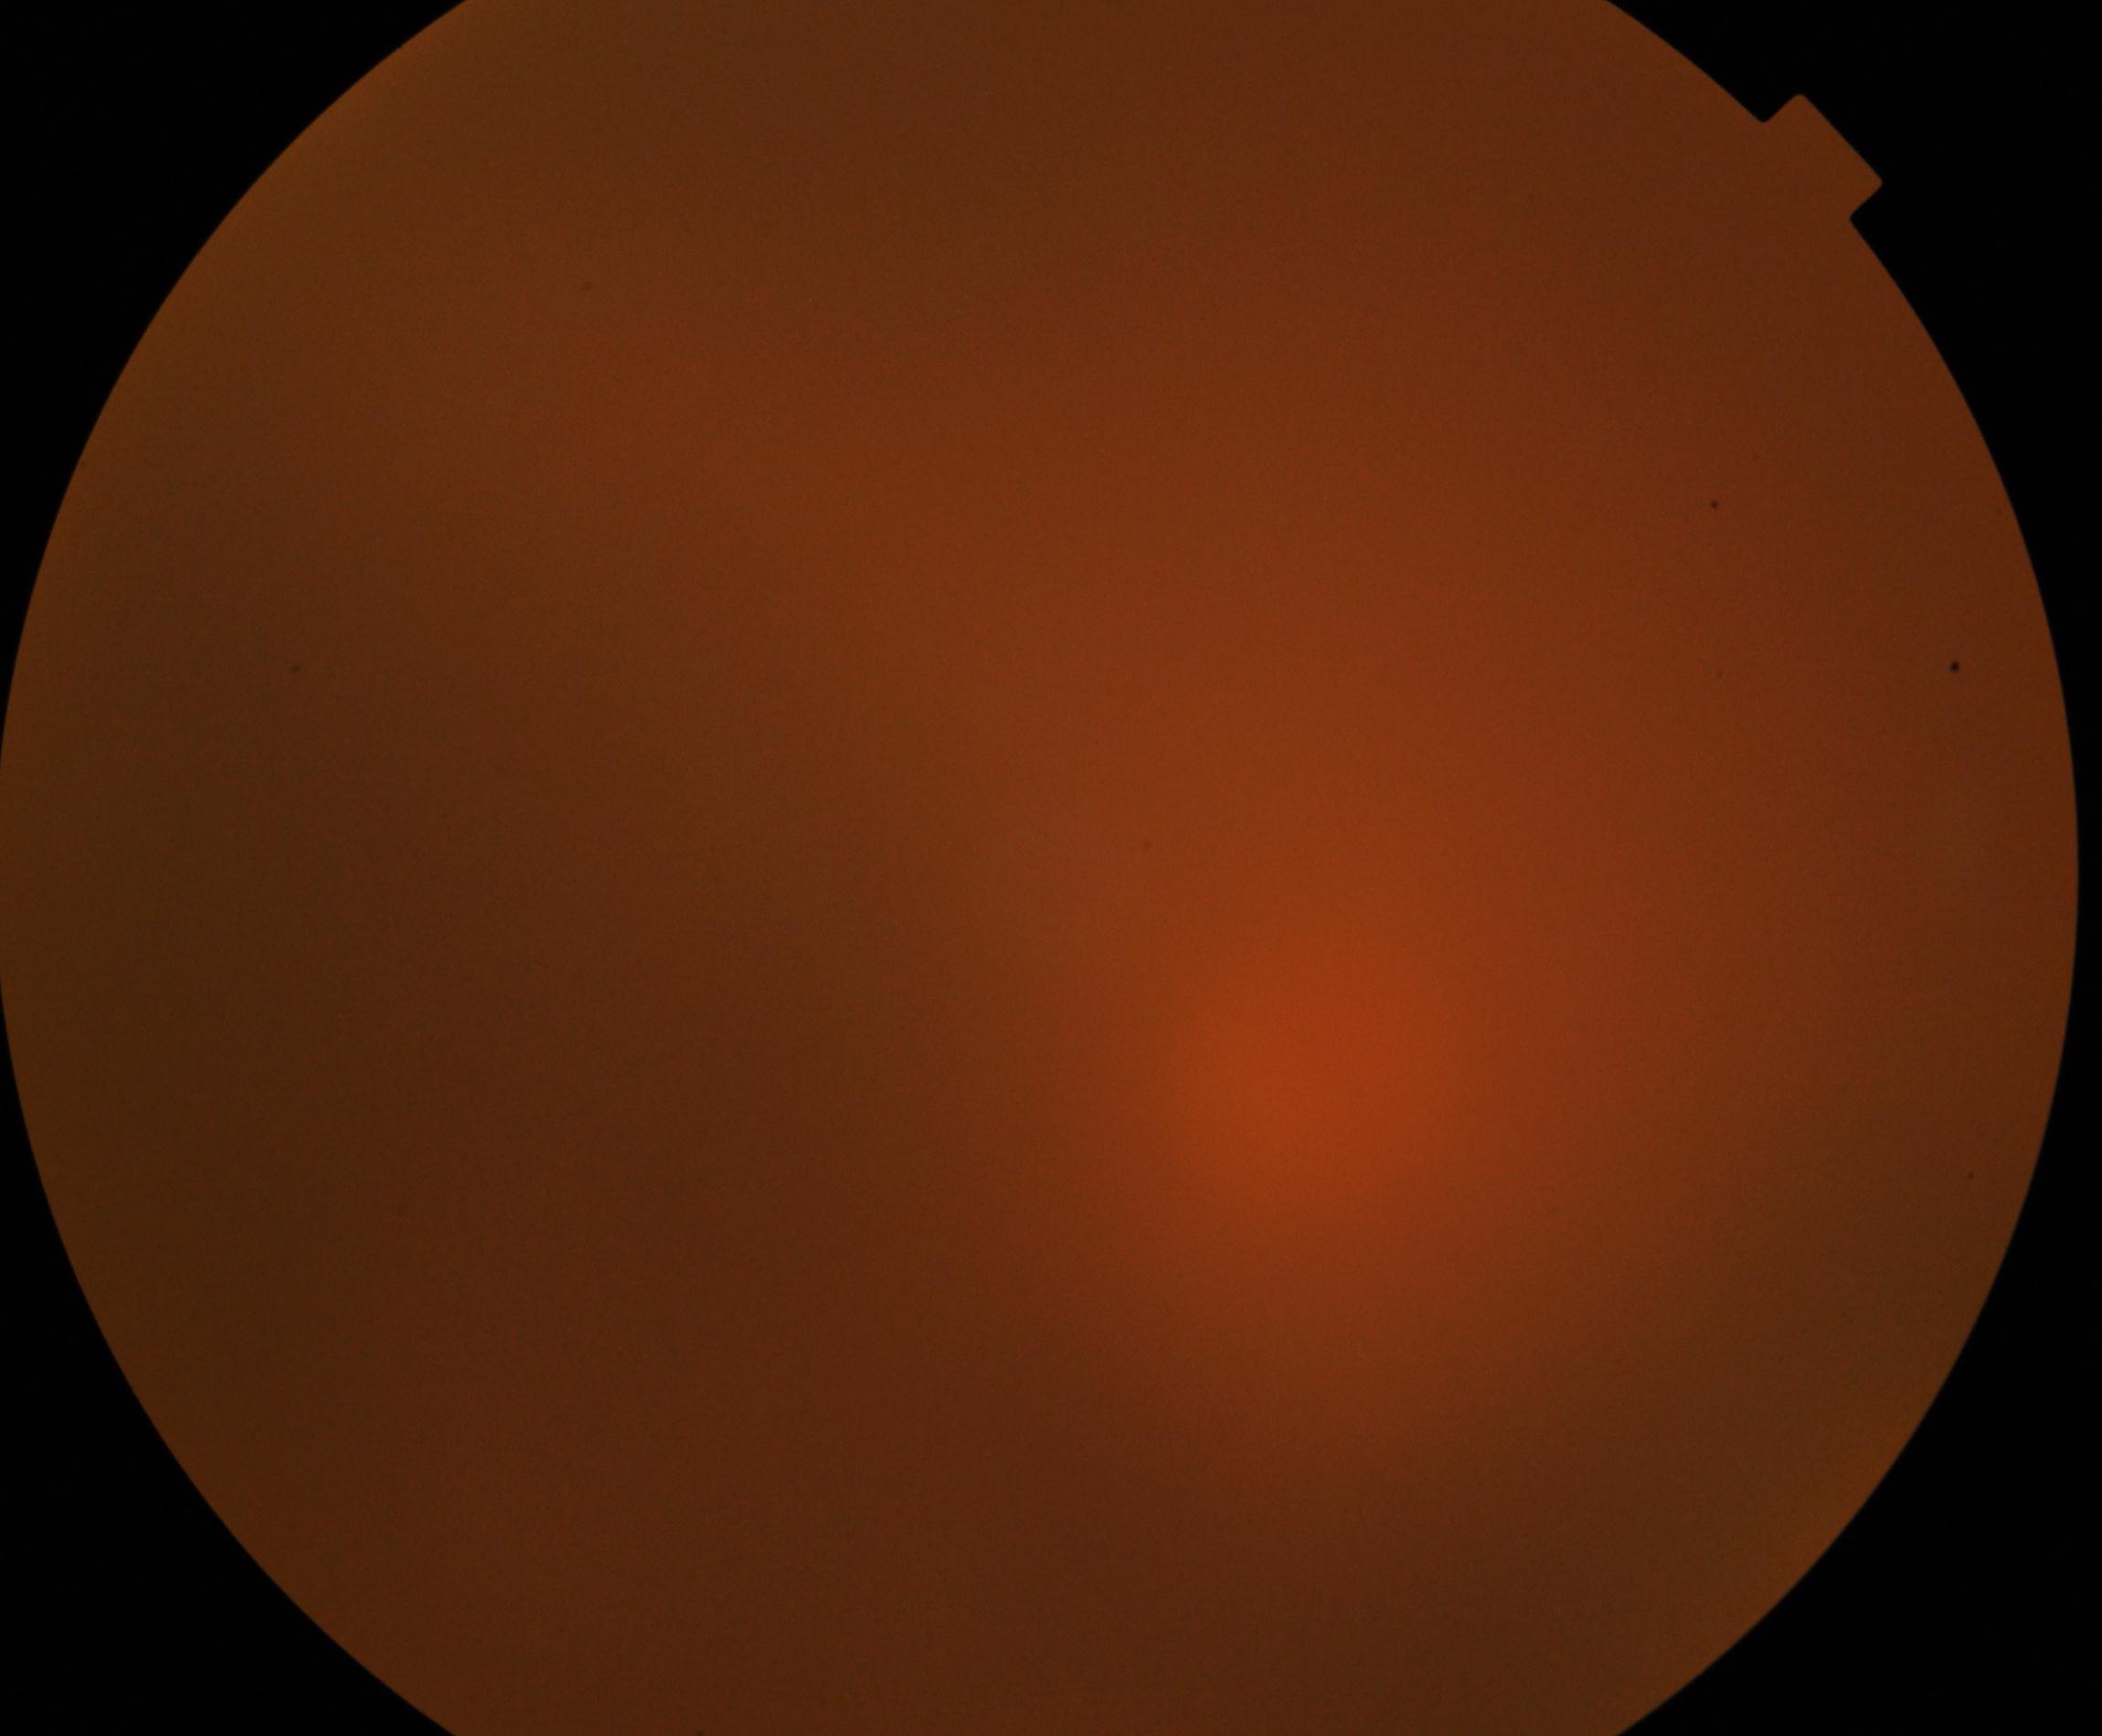

Poor-quality fundus photograph; retinal landmarks are largely obscured. Proliferative diabetic retinopathy not identified in the visible portion.